512x512:
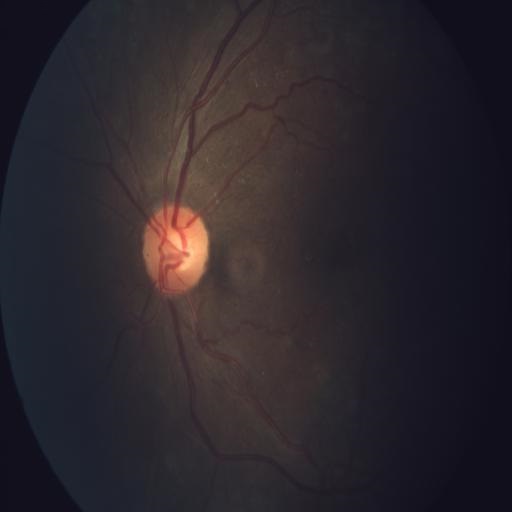

This fundus photograph shows tortuous vessels (TV).